Wide-field contact fundus photograph of an infant — 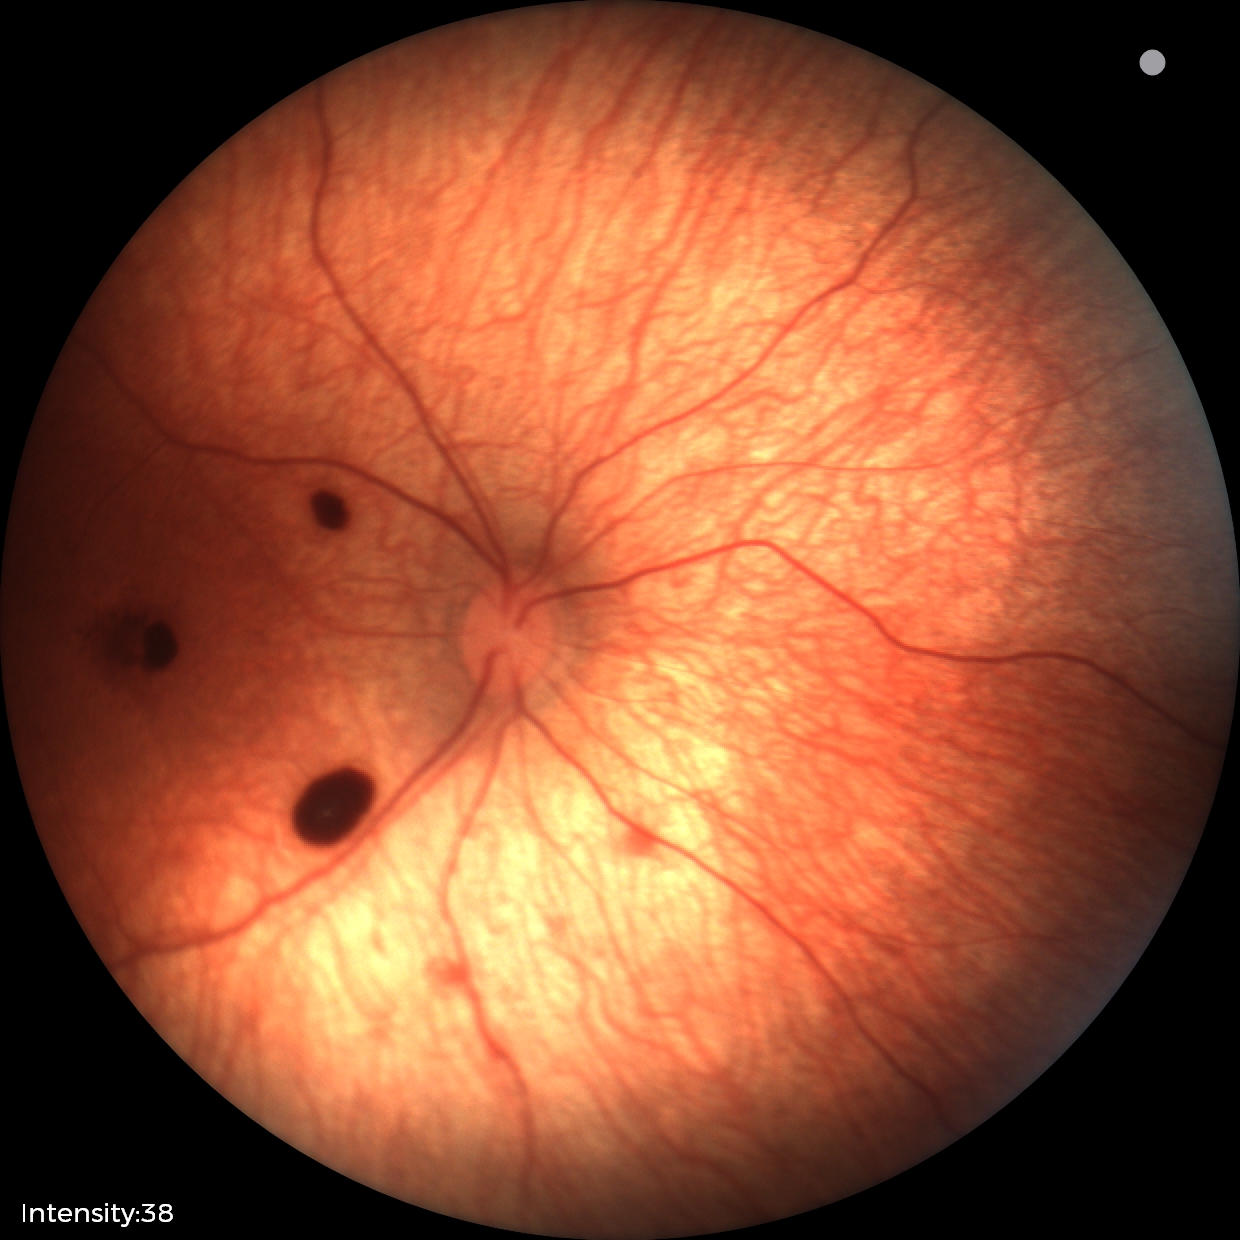 Screening: retinal hemorrhages.